1536x1152; 45° FOV — 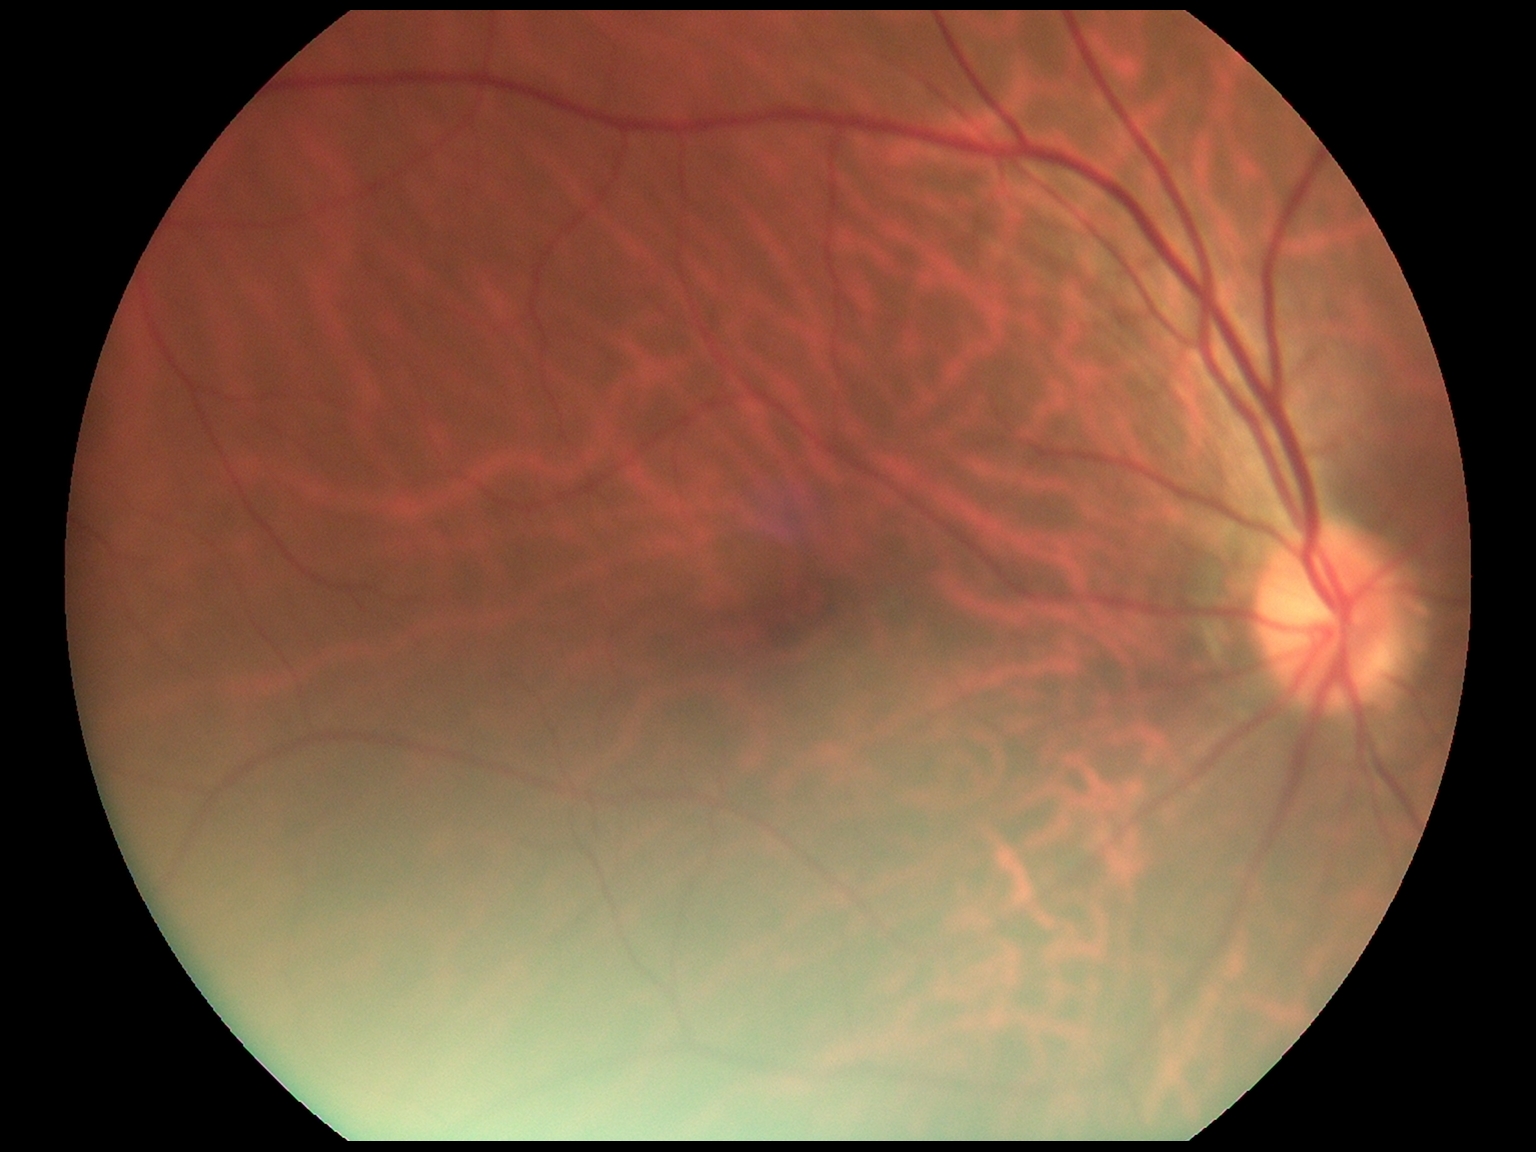
DR impression=negative for DR; diabetic retinopathy (DR)=no apparent diabetic retinopathy (grade 0).